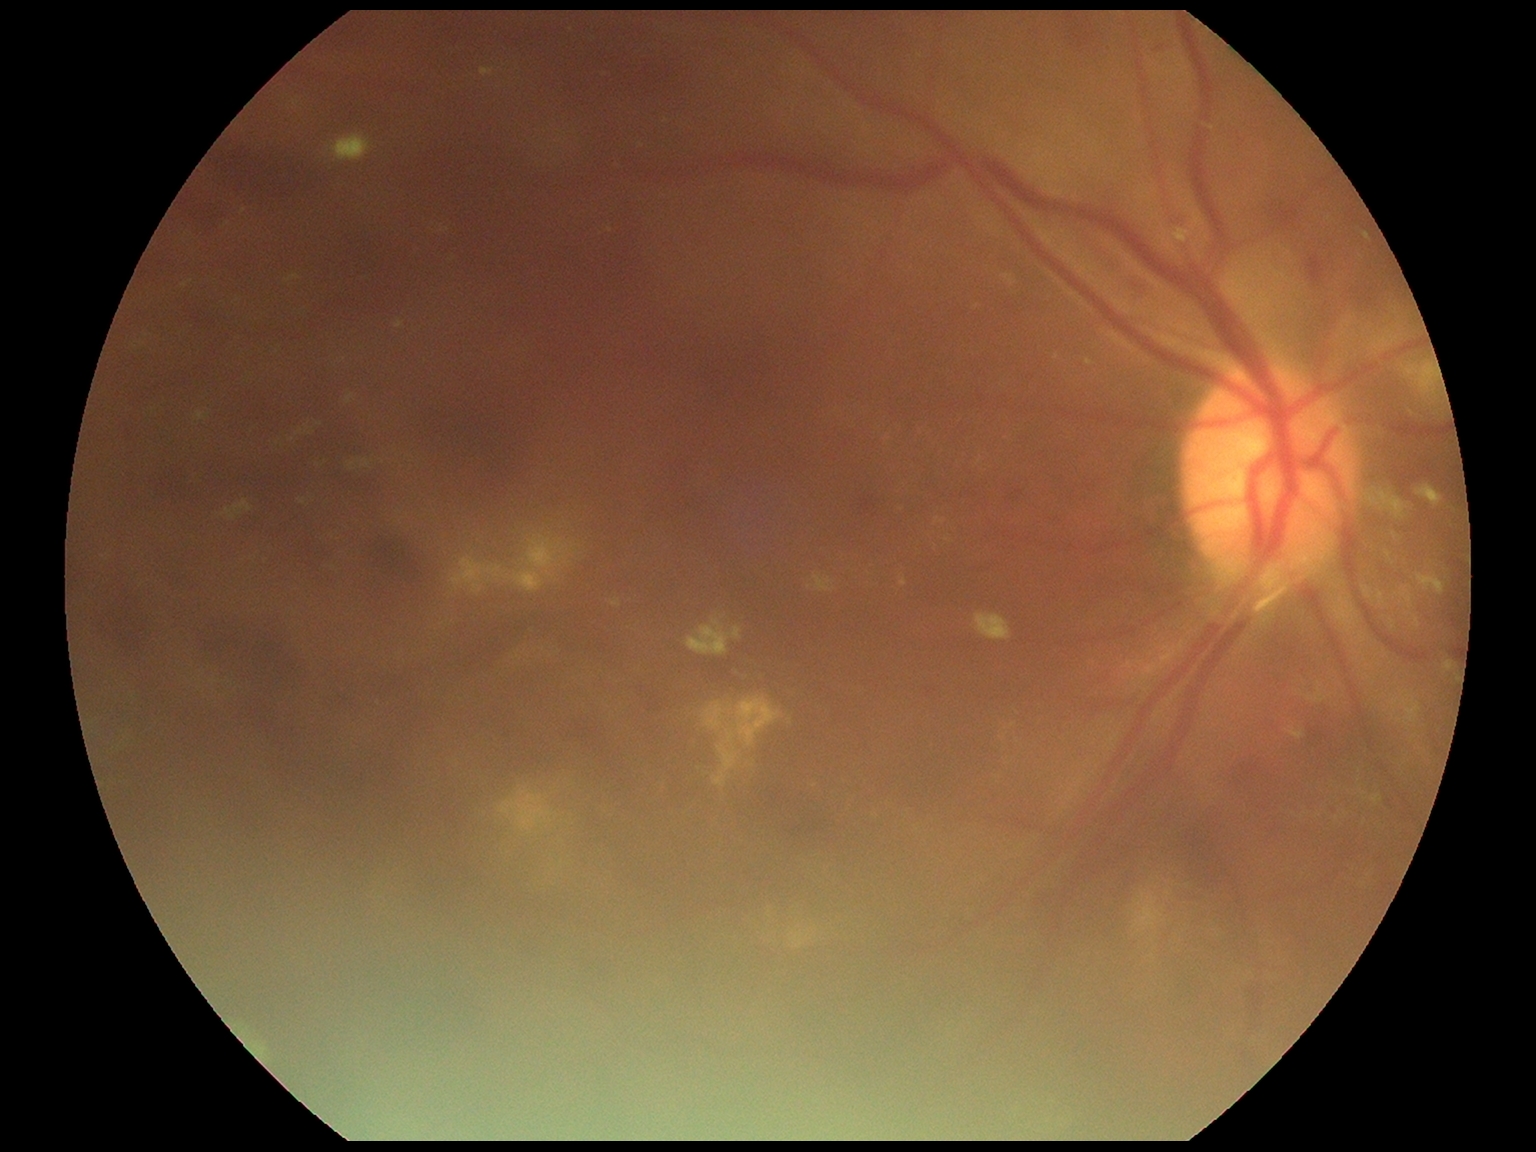
DR severity: grade 2 (moderate NPDR).